Modified Davis grading
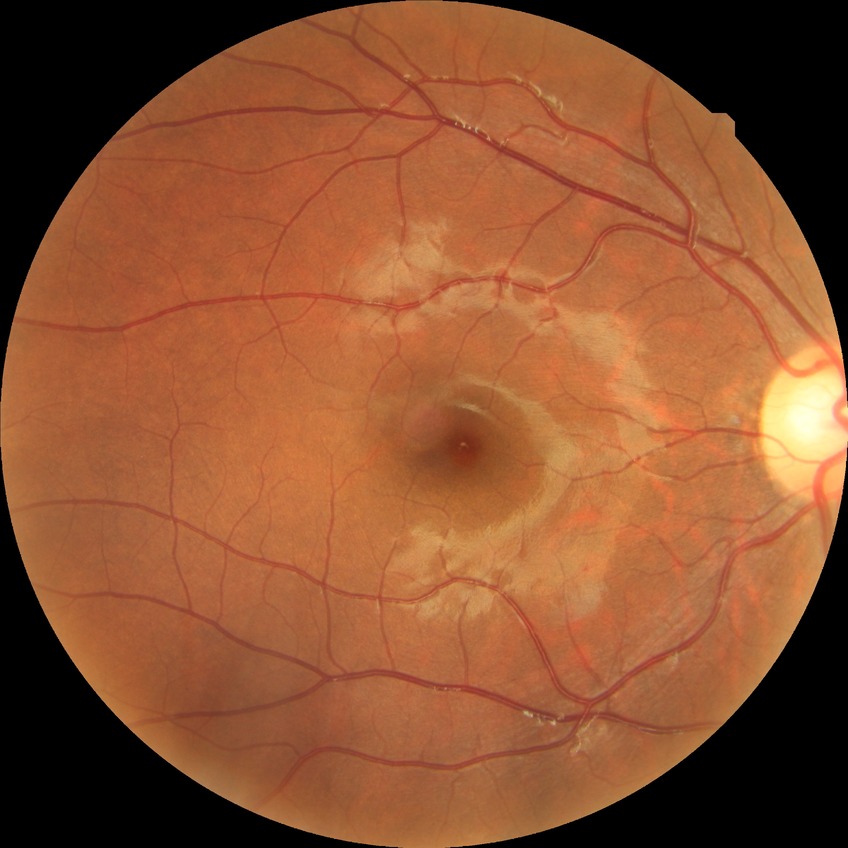

Modified Davis classification: no diabetic retinopathy.